45° FOV:
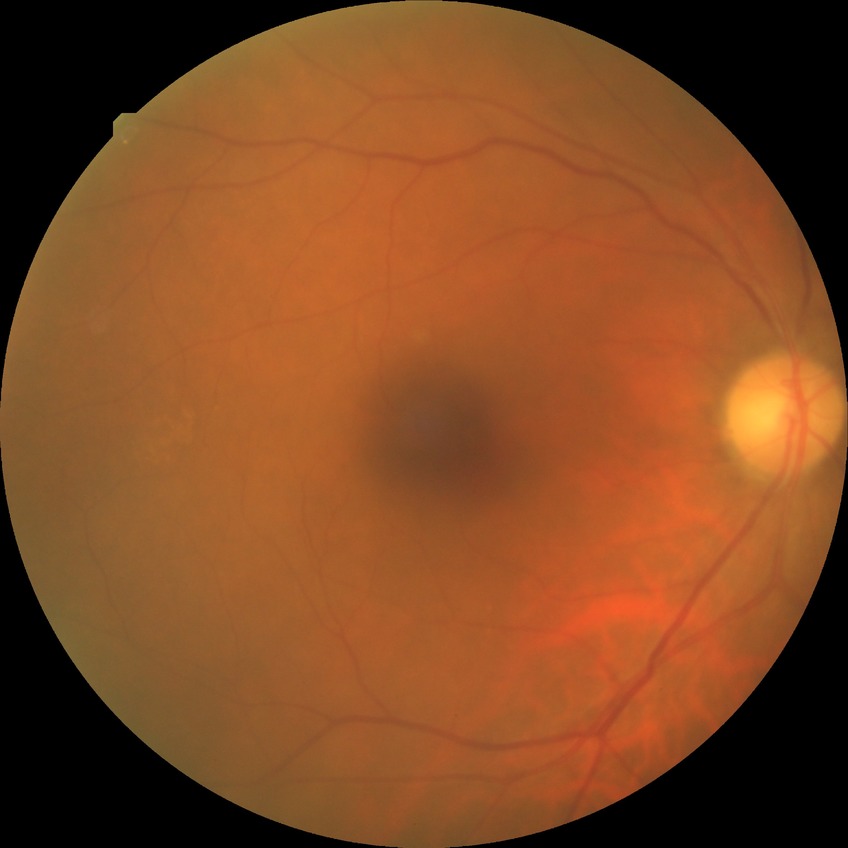
Diabetic retinopathy (DR) is NDR (no diabetic retinopathy).